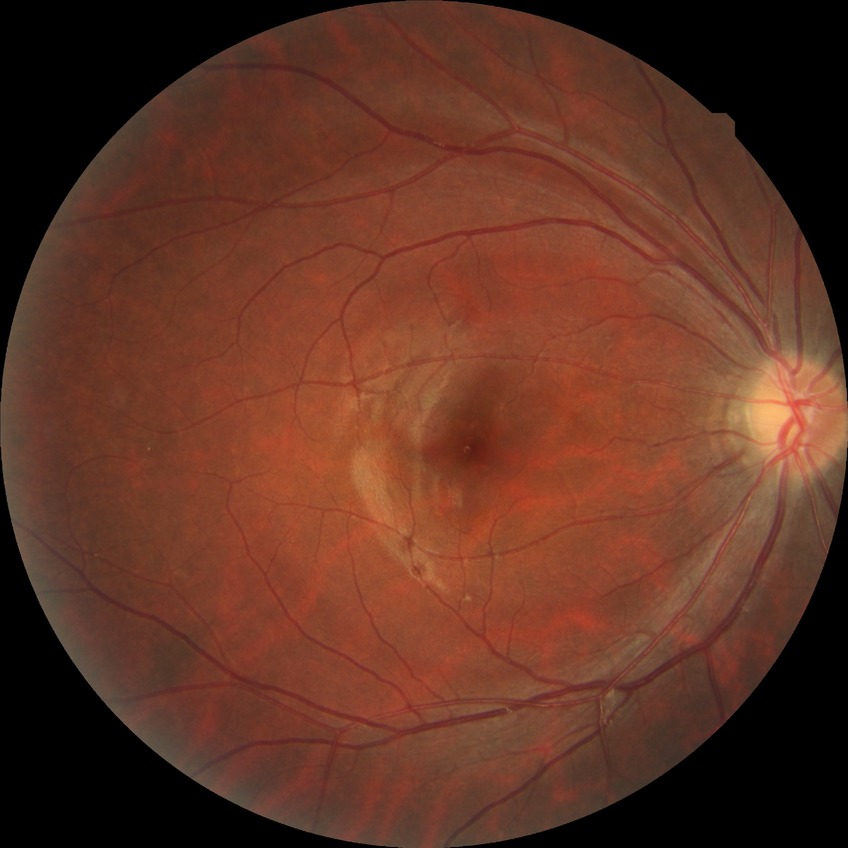

Diabetic retinopathy (DR) is no diabetic retinopathy (NDR).